Fundus photo: 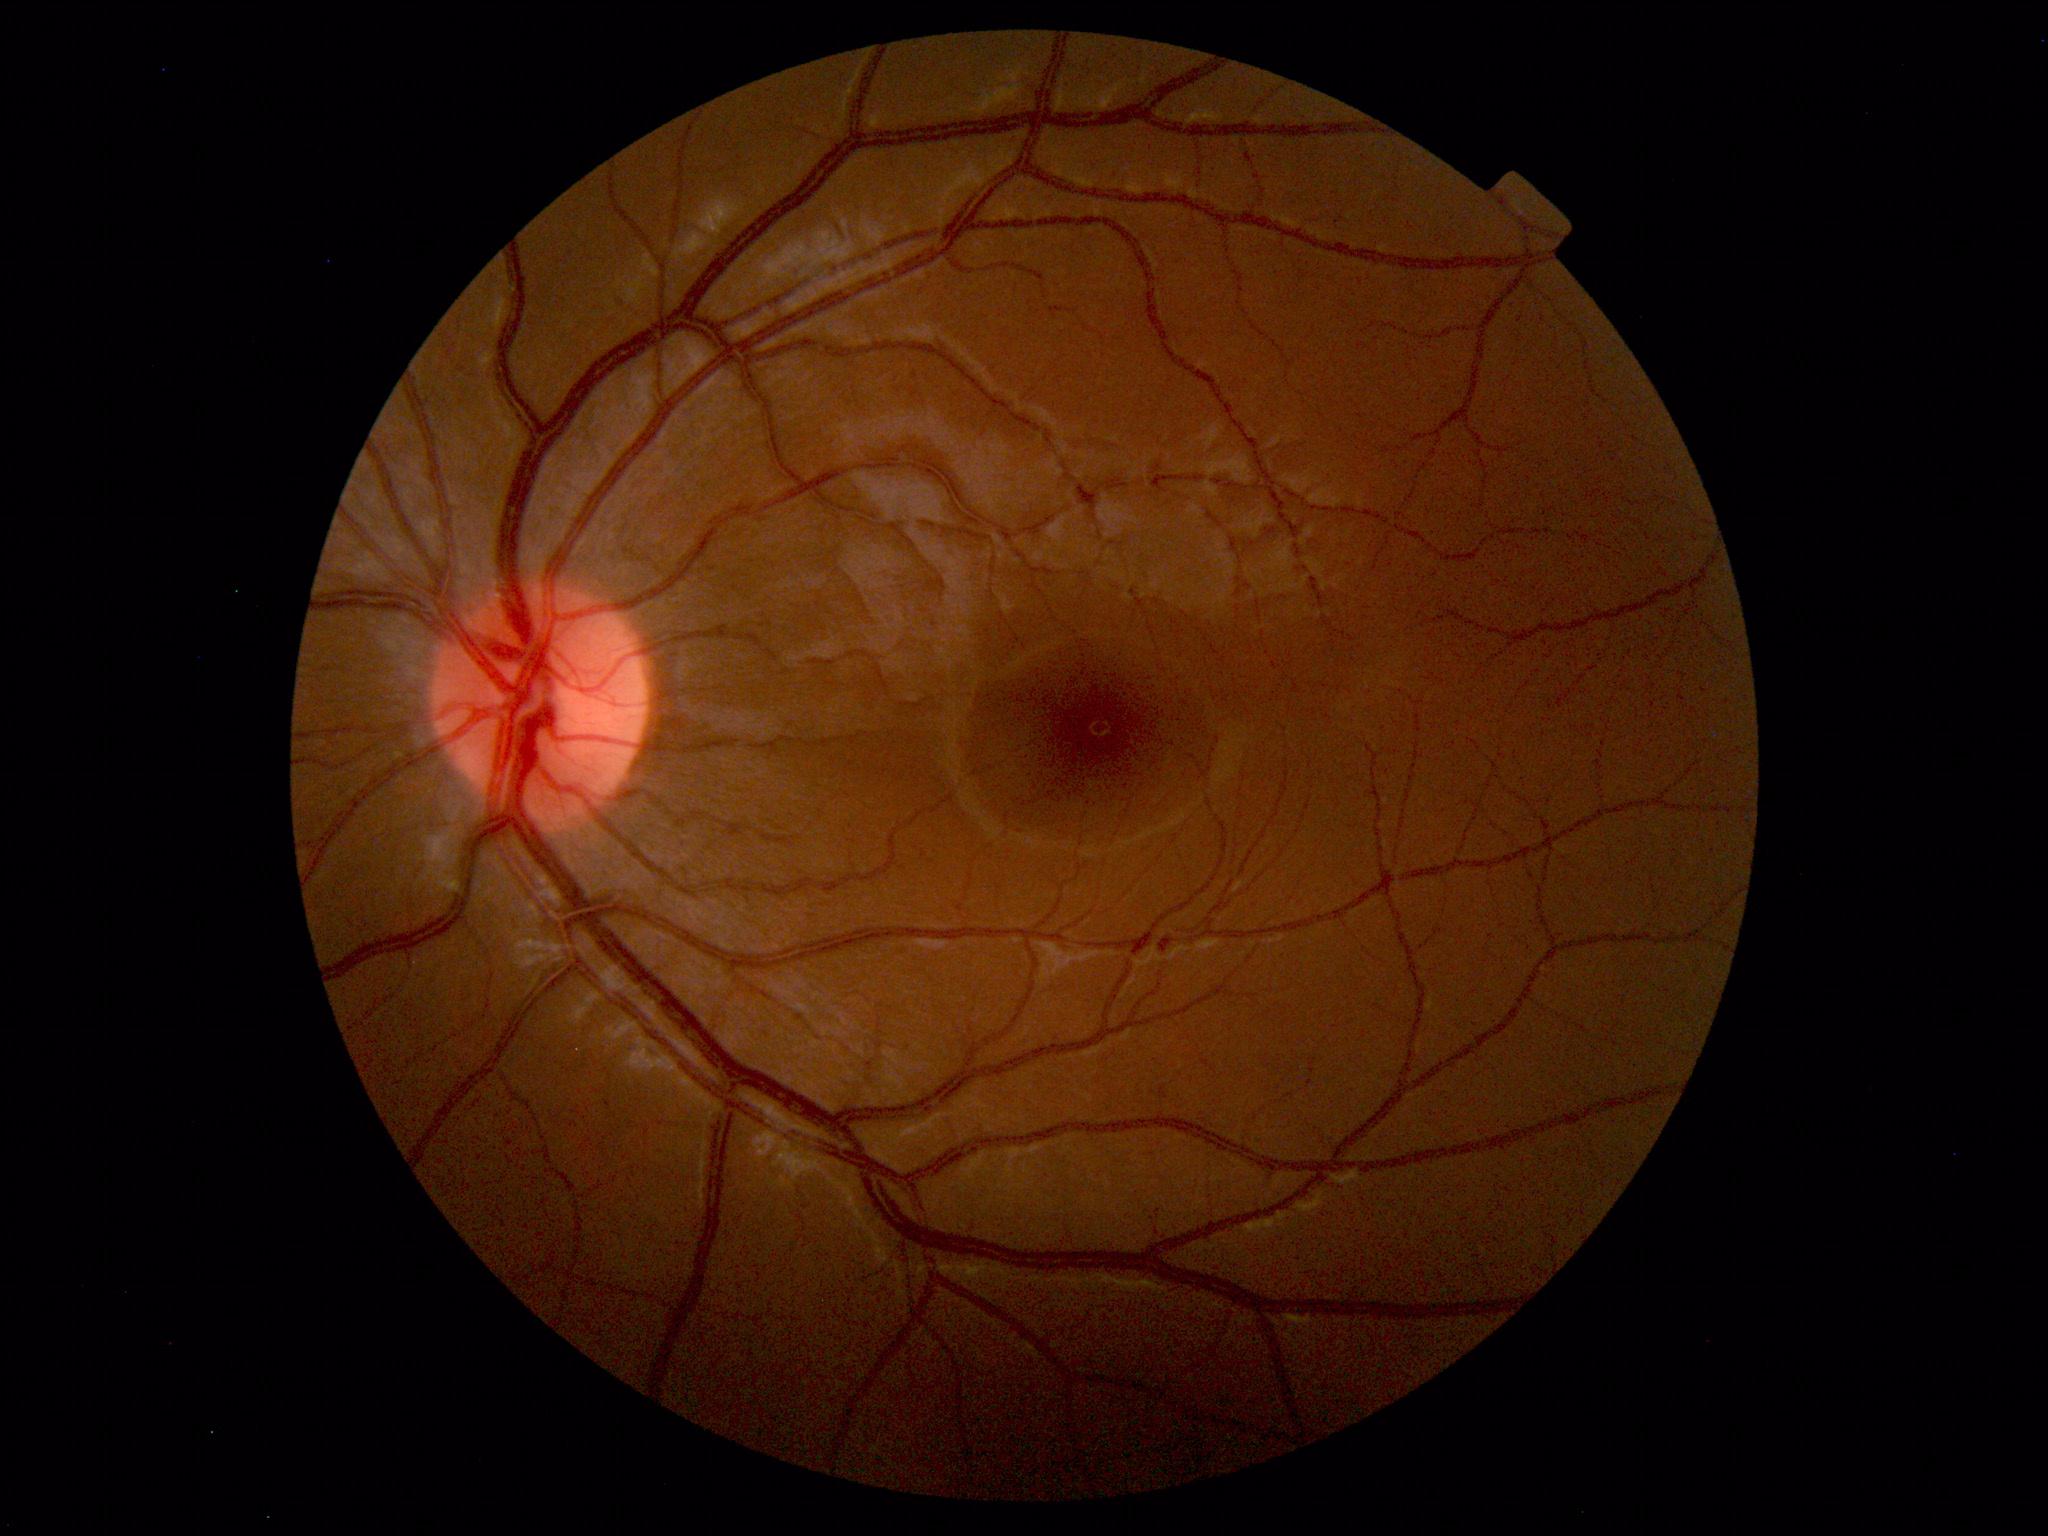 The fundus appears normal with no pathological findings.